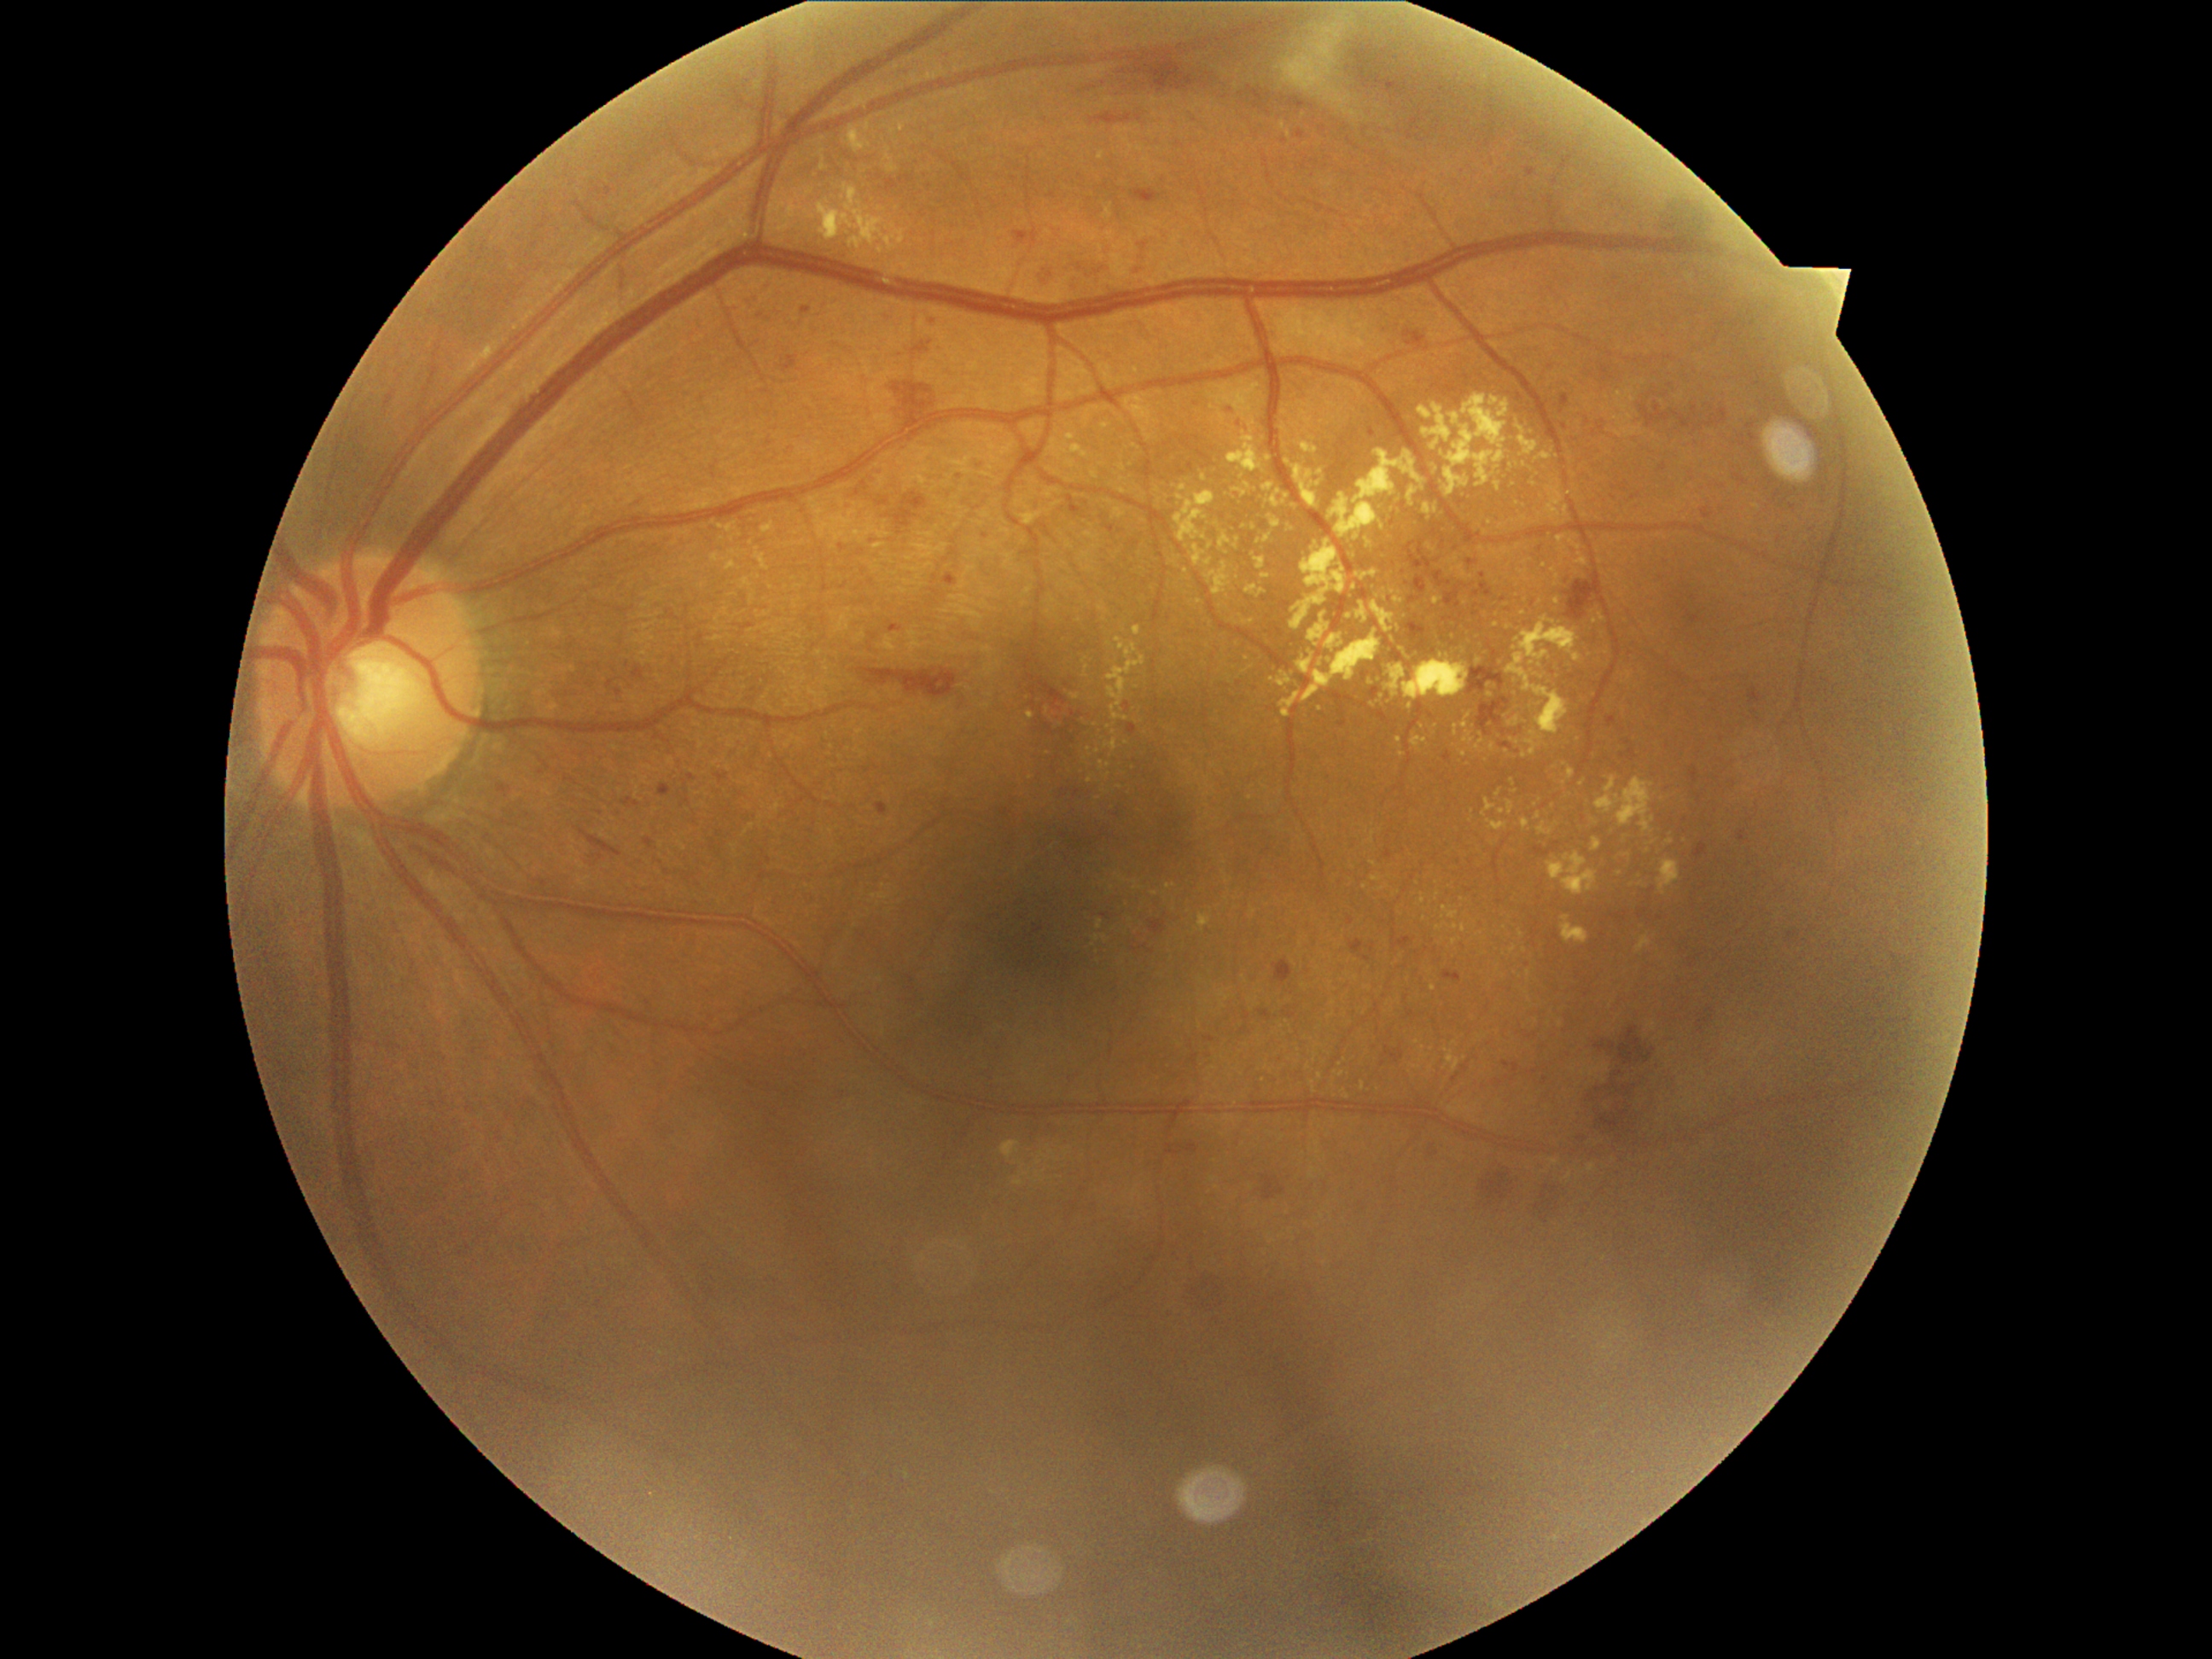
Diabetic retinopathy (DR) is grade 2. Hard exudates (EXs) (partial list) at bbox=[1552, 568, 1559, 581] | bbox=[1568, 769, 1575, 781] | bbox=[1103, 774, 1112, 779] | bbox=[1641, 878, 1648, 887] | bbox=[1233, 482, 1250, 498] | bbox=[1527, 728, 1544, 757] | bbox=[1421, 404, 1453, 451] | bbox=[1455, 726, 1458, 735] | bbox=[1523, 465, 1534, 472] | bbox=[1044, 743, 1052, 757] | bbox=[1476, 733, 1486, 754]. Additional small EXs near (1754,775) | (1403,650) | (1285,502) | (1465,1058) | (1595,622) | (1229,678) | (1455,636) | (1565,554).